Phoenix ICON wide-field infant fundus image — 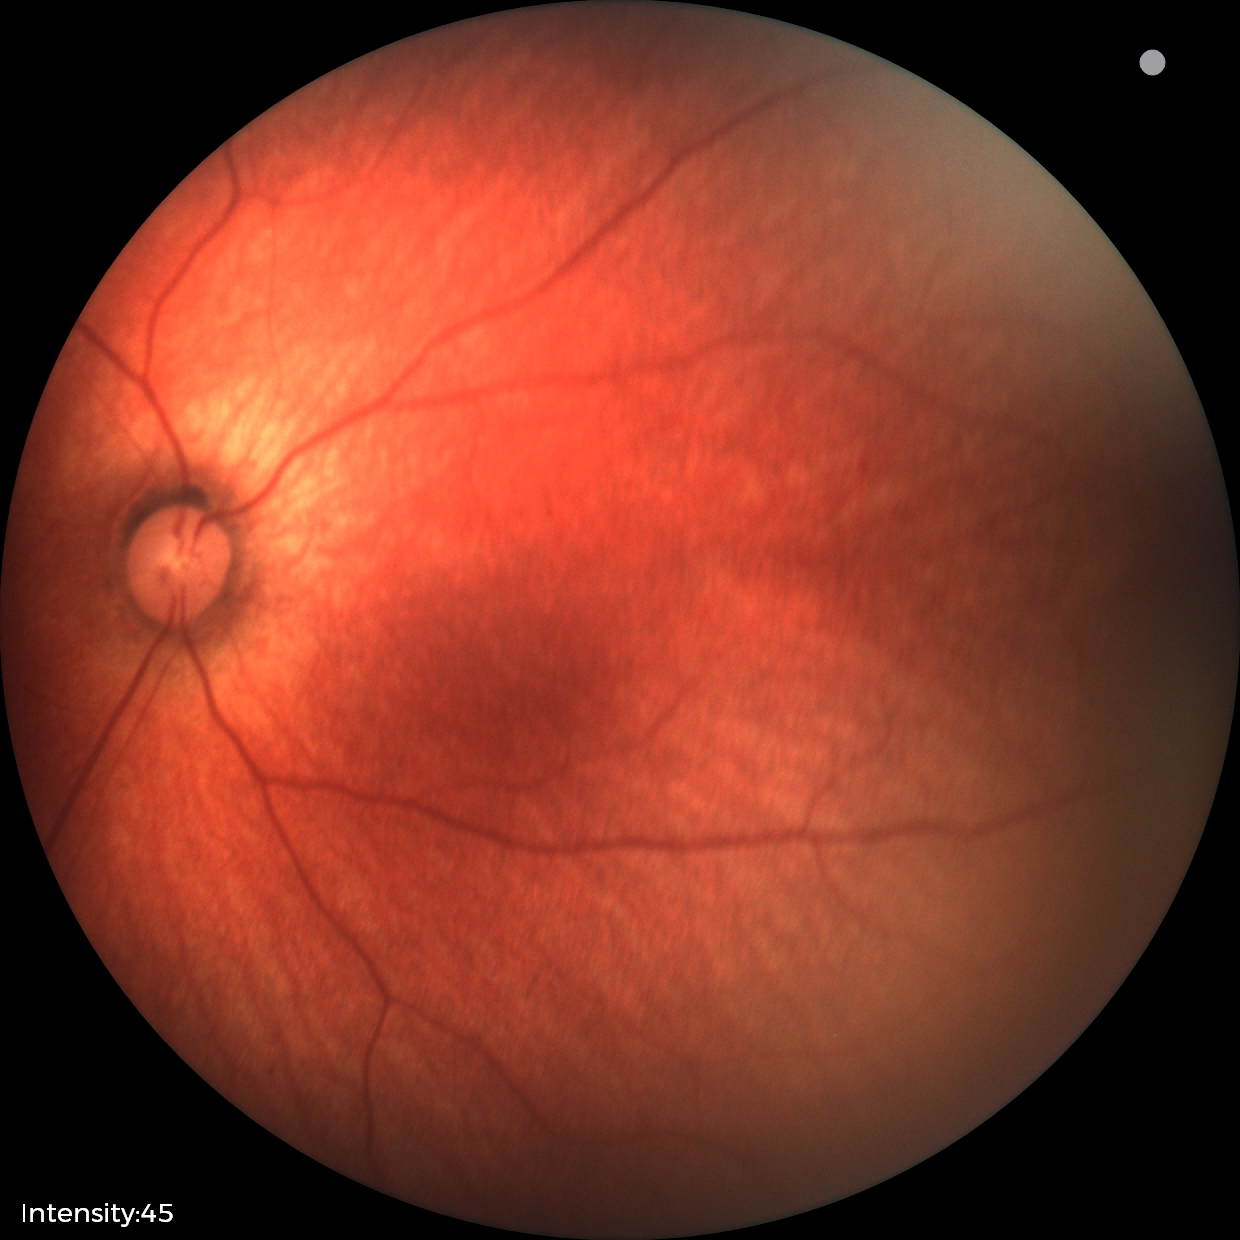 Assessment: normal retinal appearance.